Wide-field contact fundus photograph of an infant: 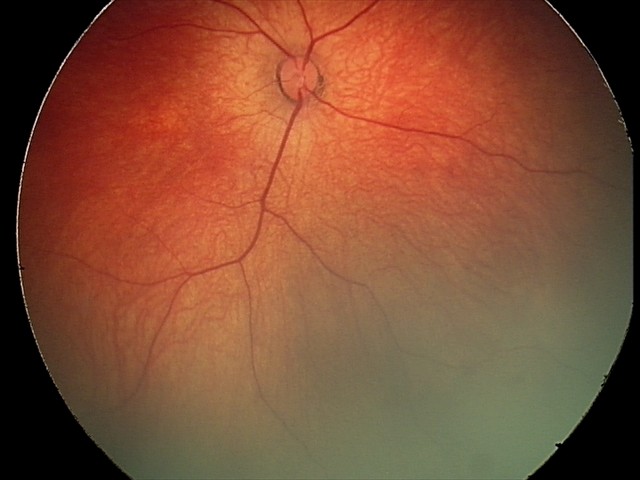

Series diagnosed as retinal hemorrhages.